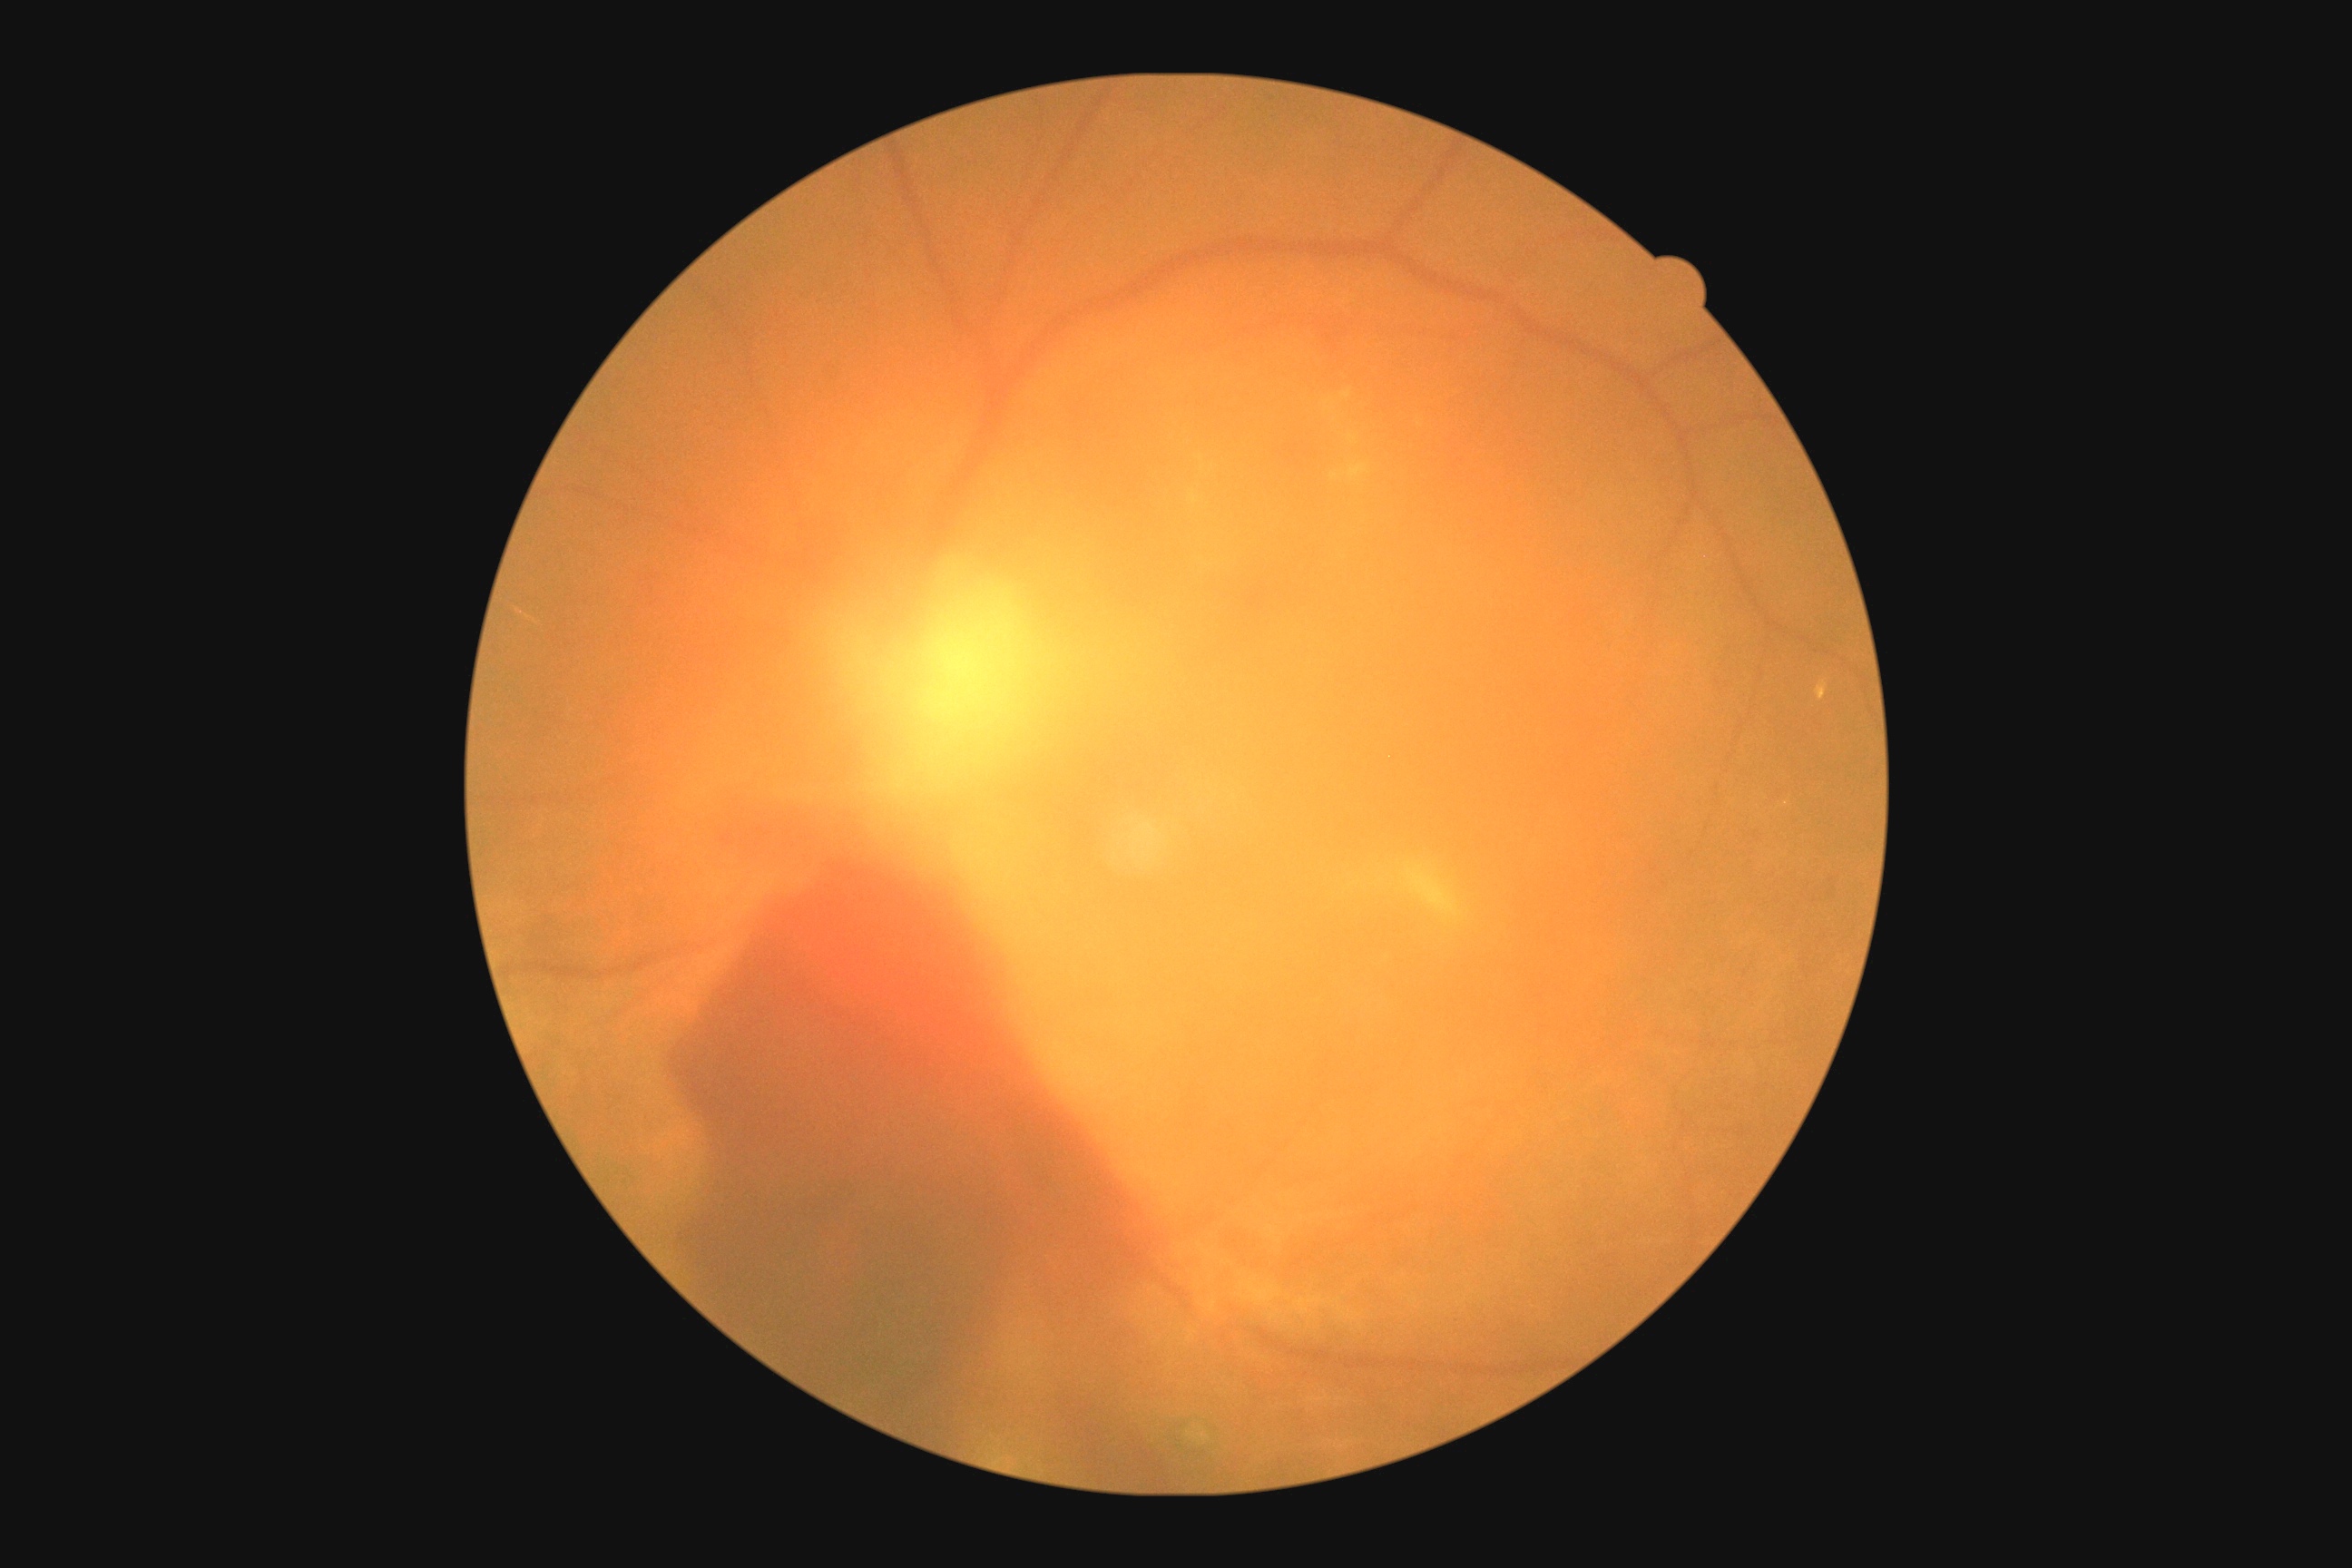
Diabetic retinopathy grade: proliferative diabetic retinopathy (4).
Disease class: proliferative diabetic retinopathy.